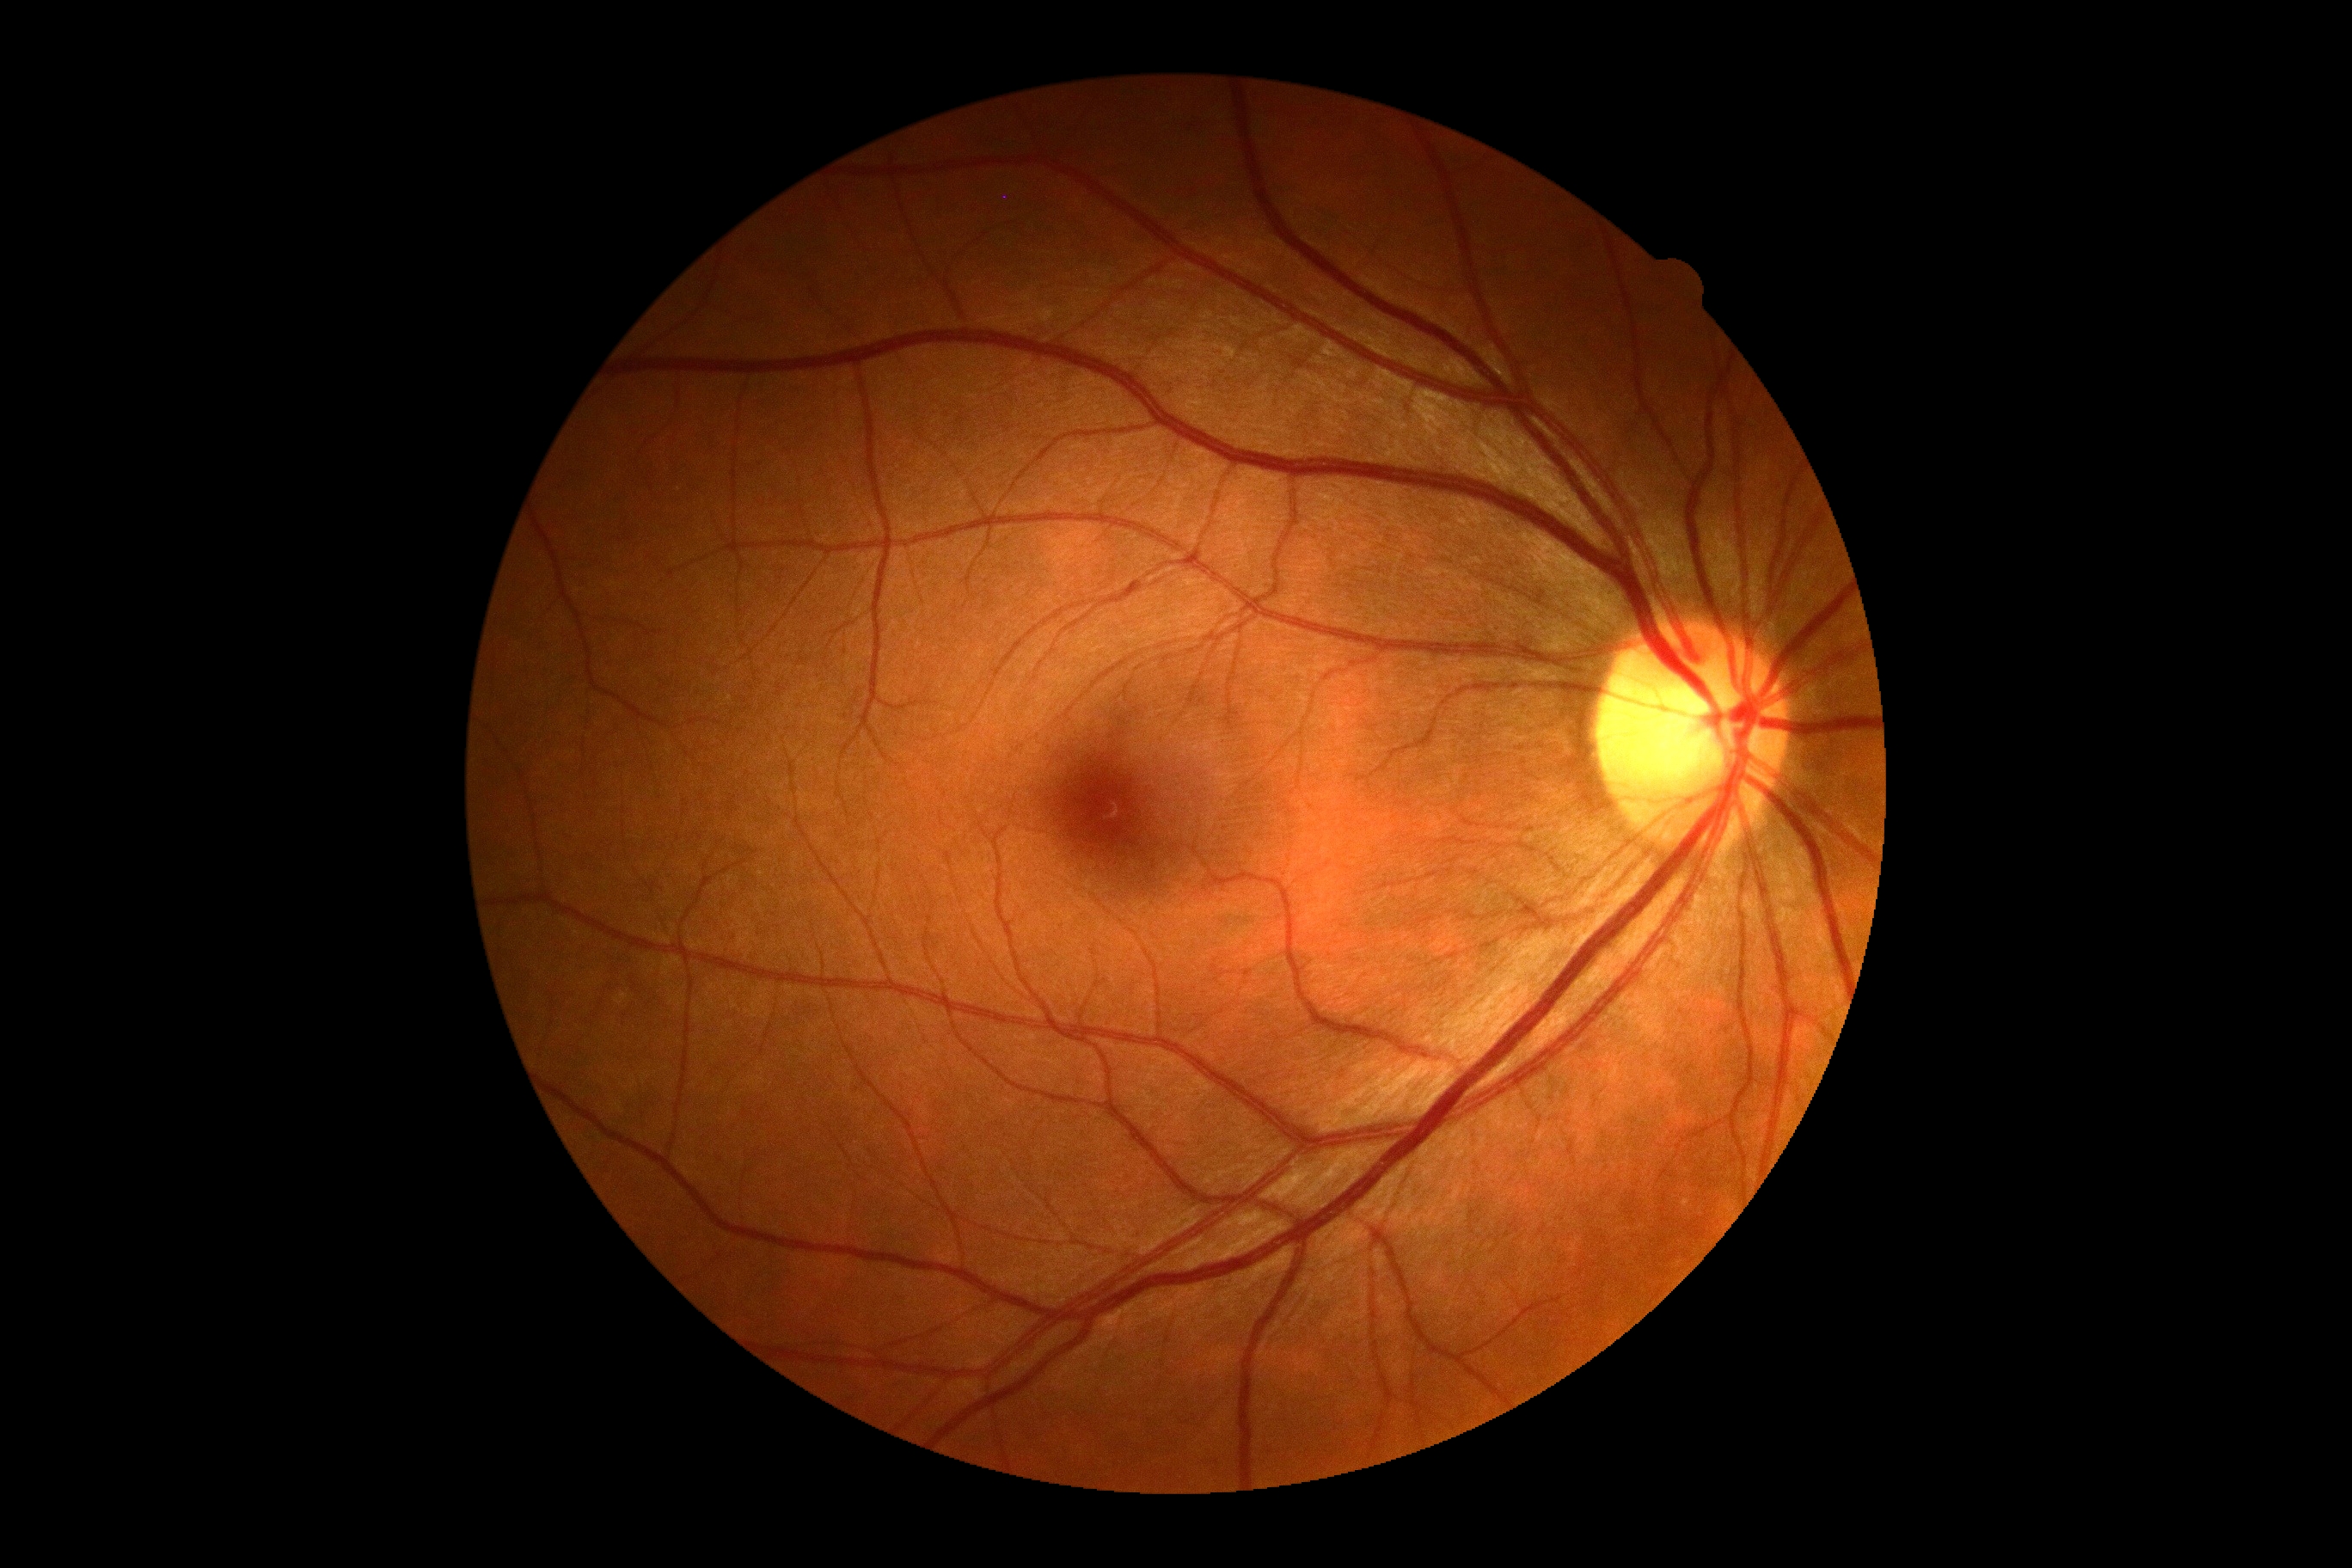
Diabetic retinopathy grade is 0 (no apparent retinopathy).
No diabetic retinal disease findings.